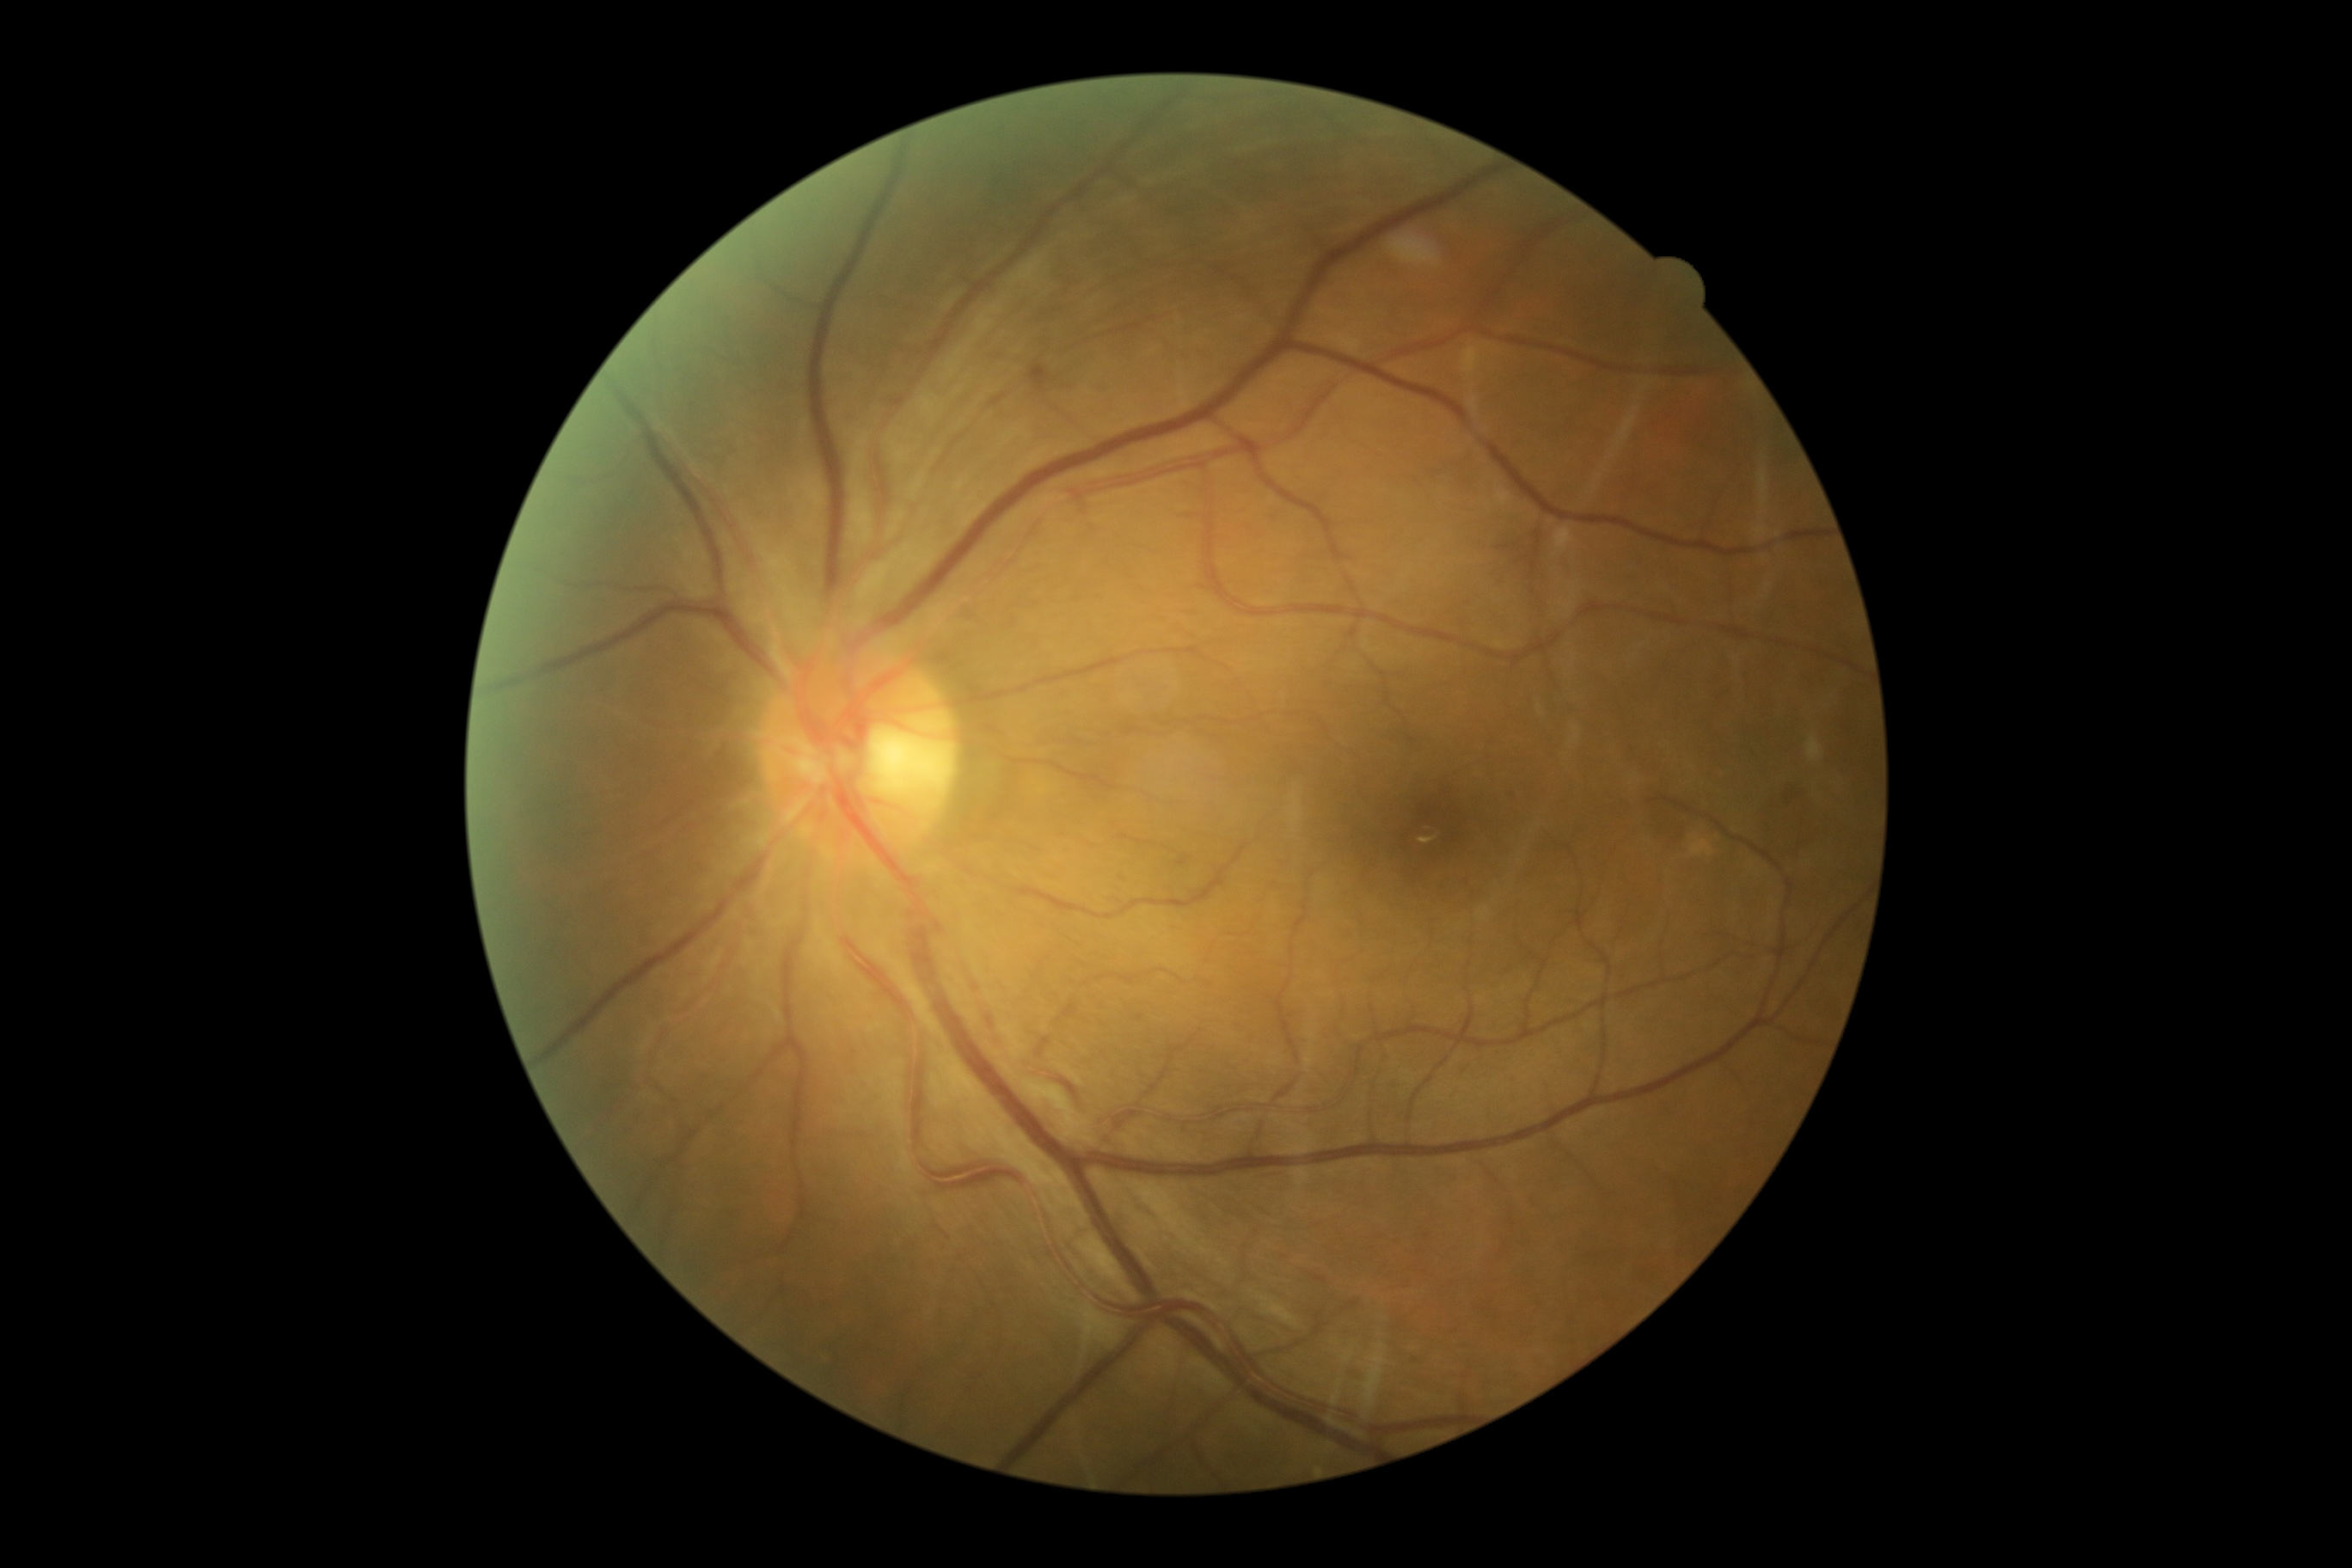

Retinopathy grade is mild NPDR (1).